Nonmydriatic. Diabetic retinopathy graded by the modified Davis classification — 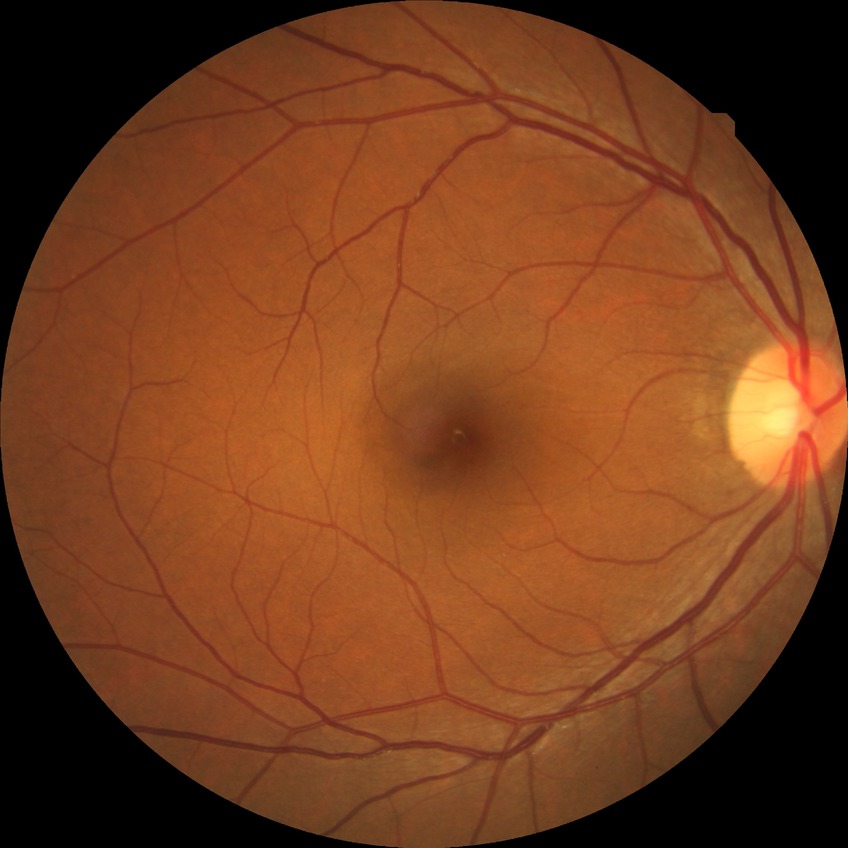 • DR impression — negative for DR
• Davis grade — NDR